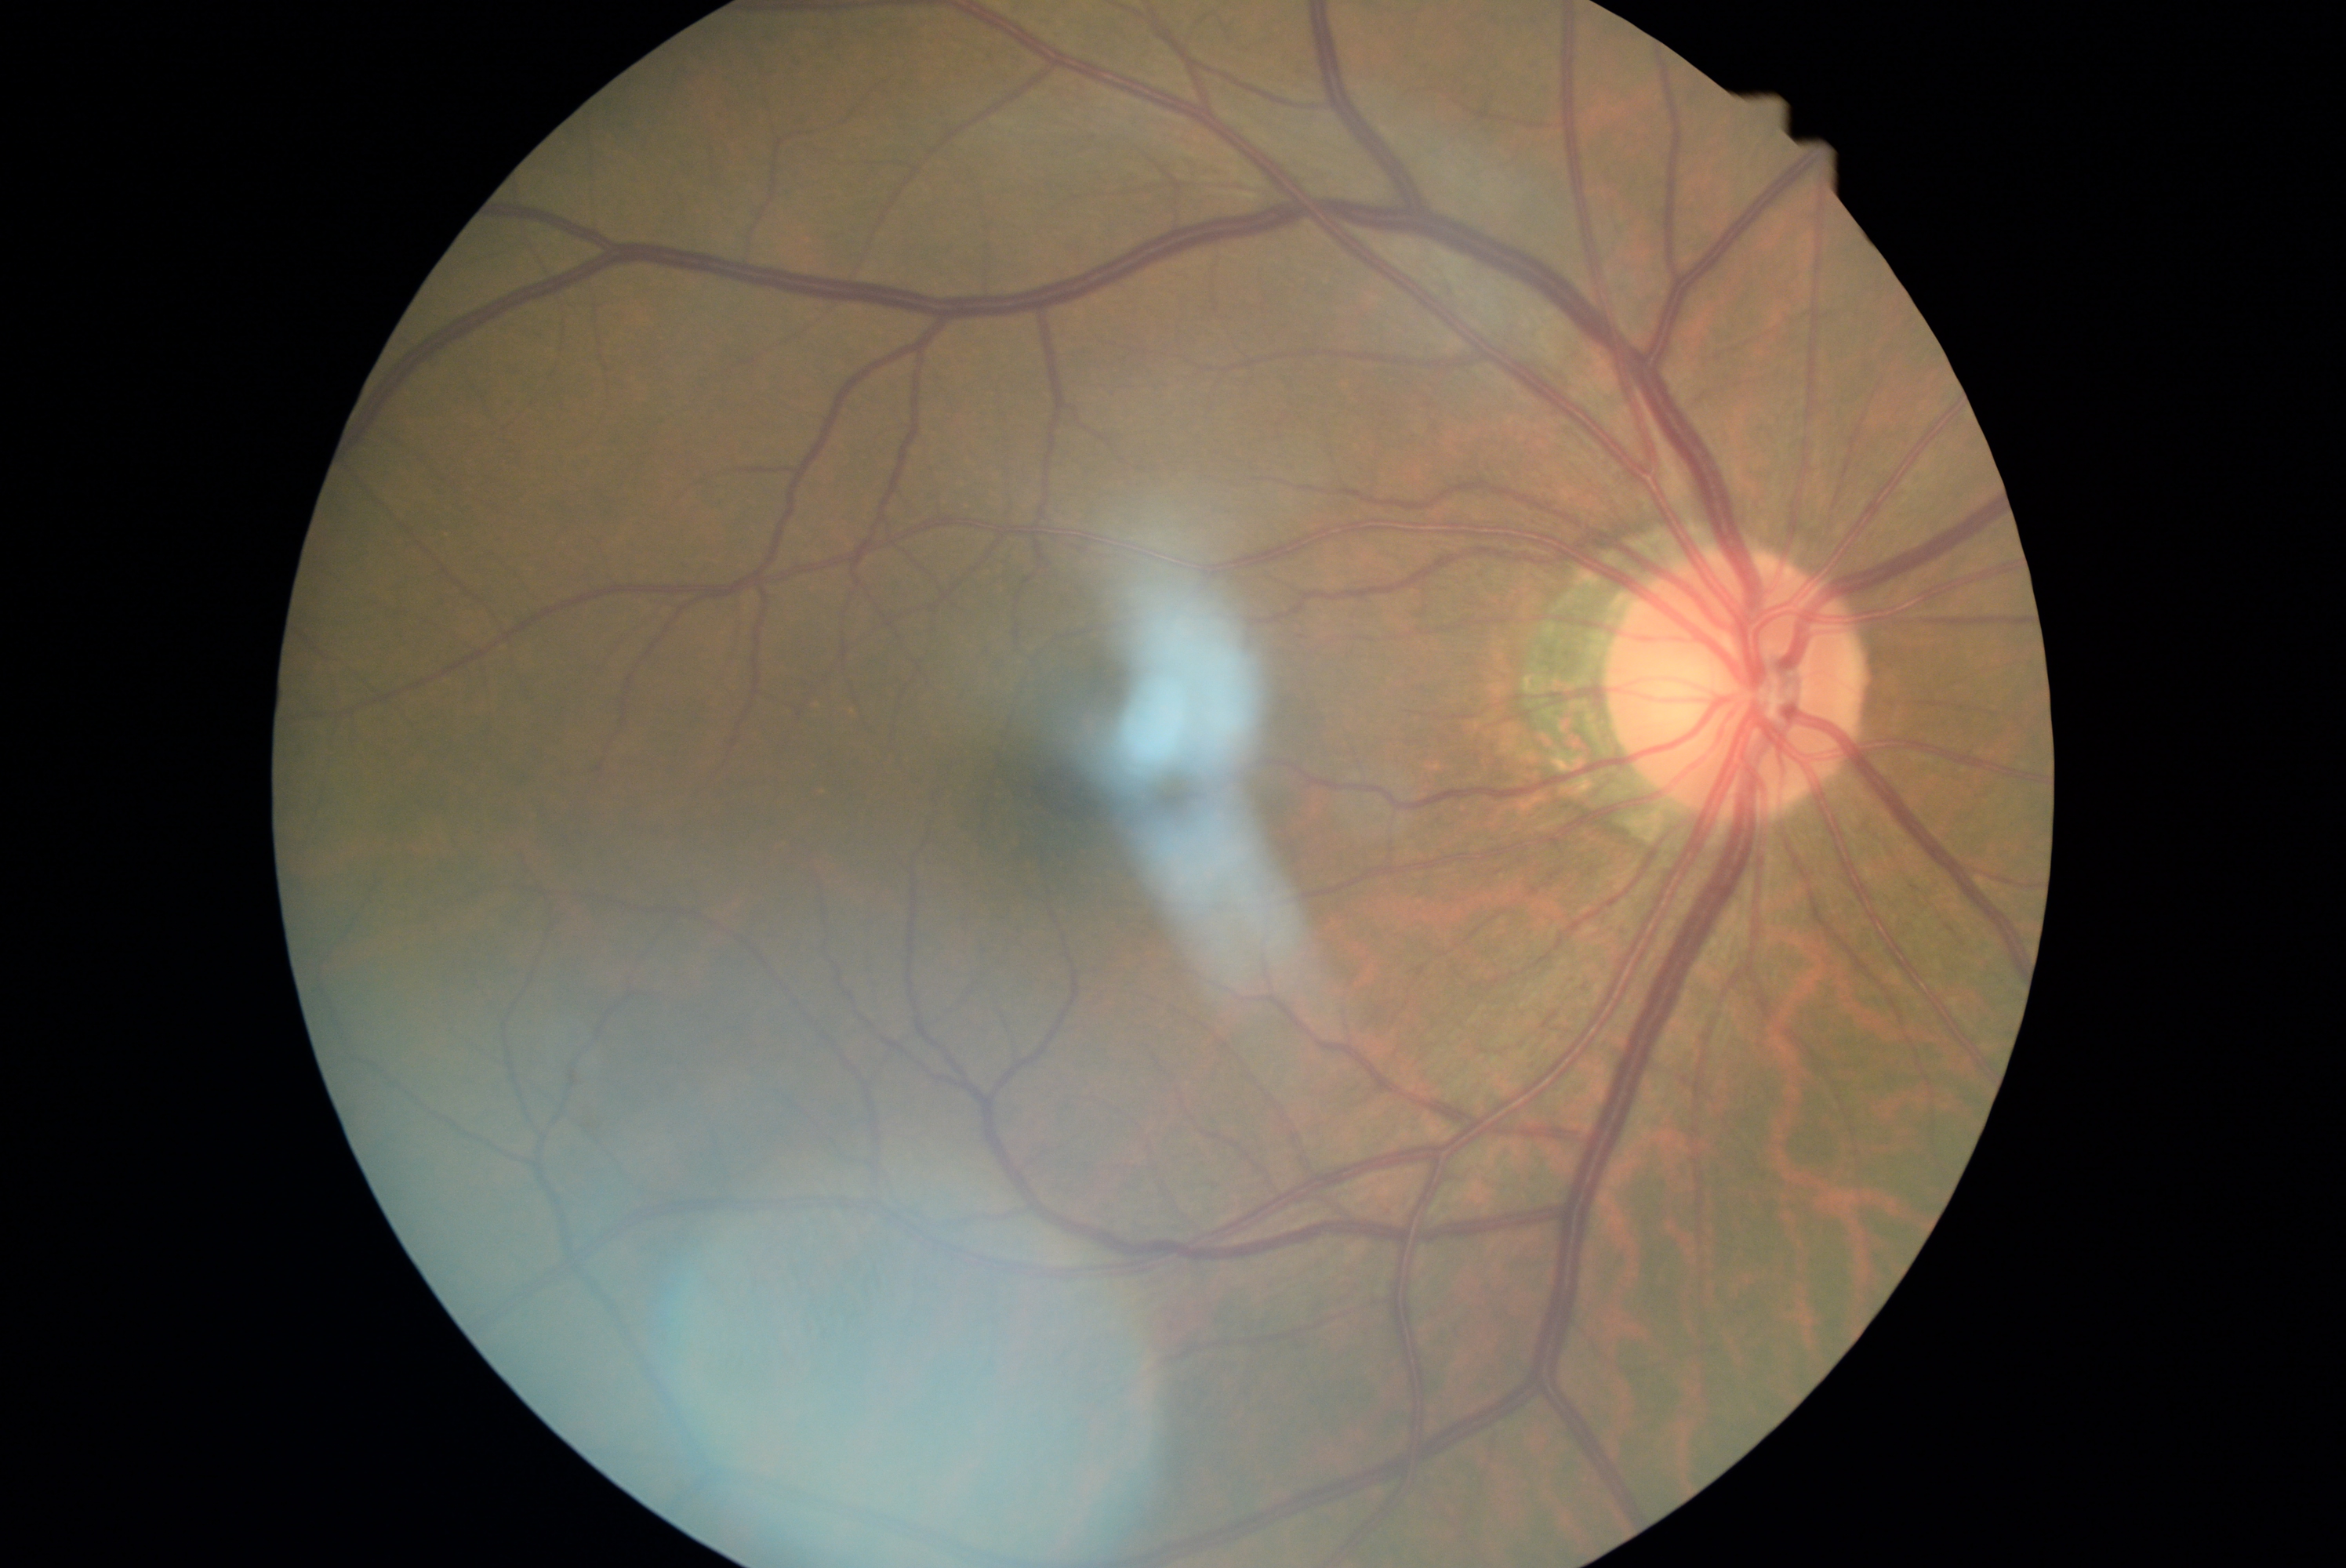
DR severity: 0.